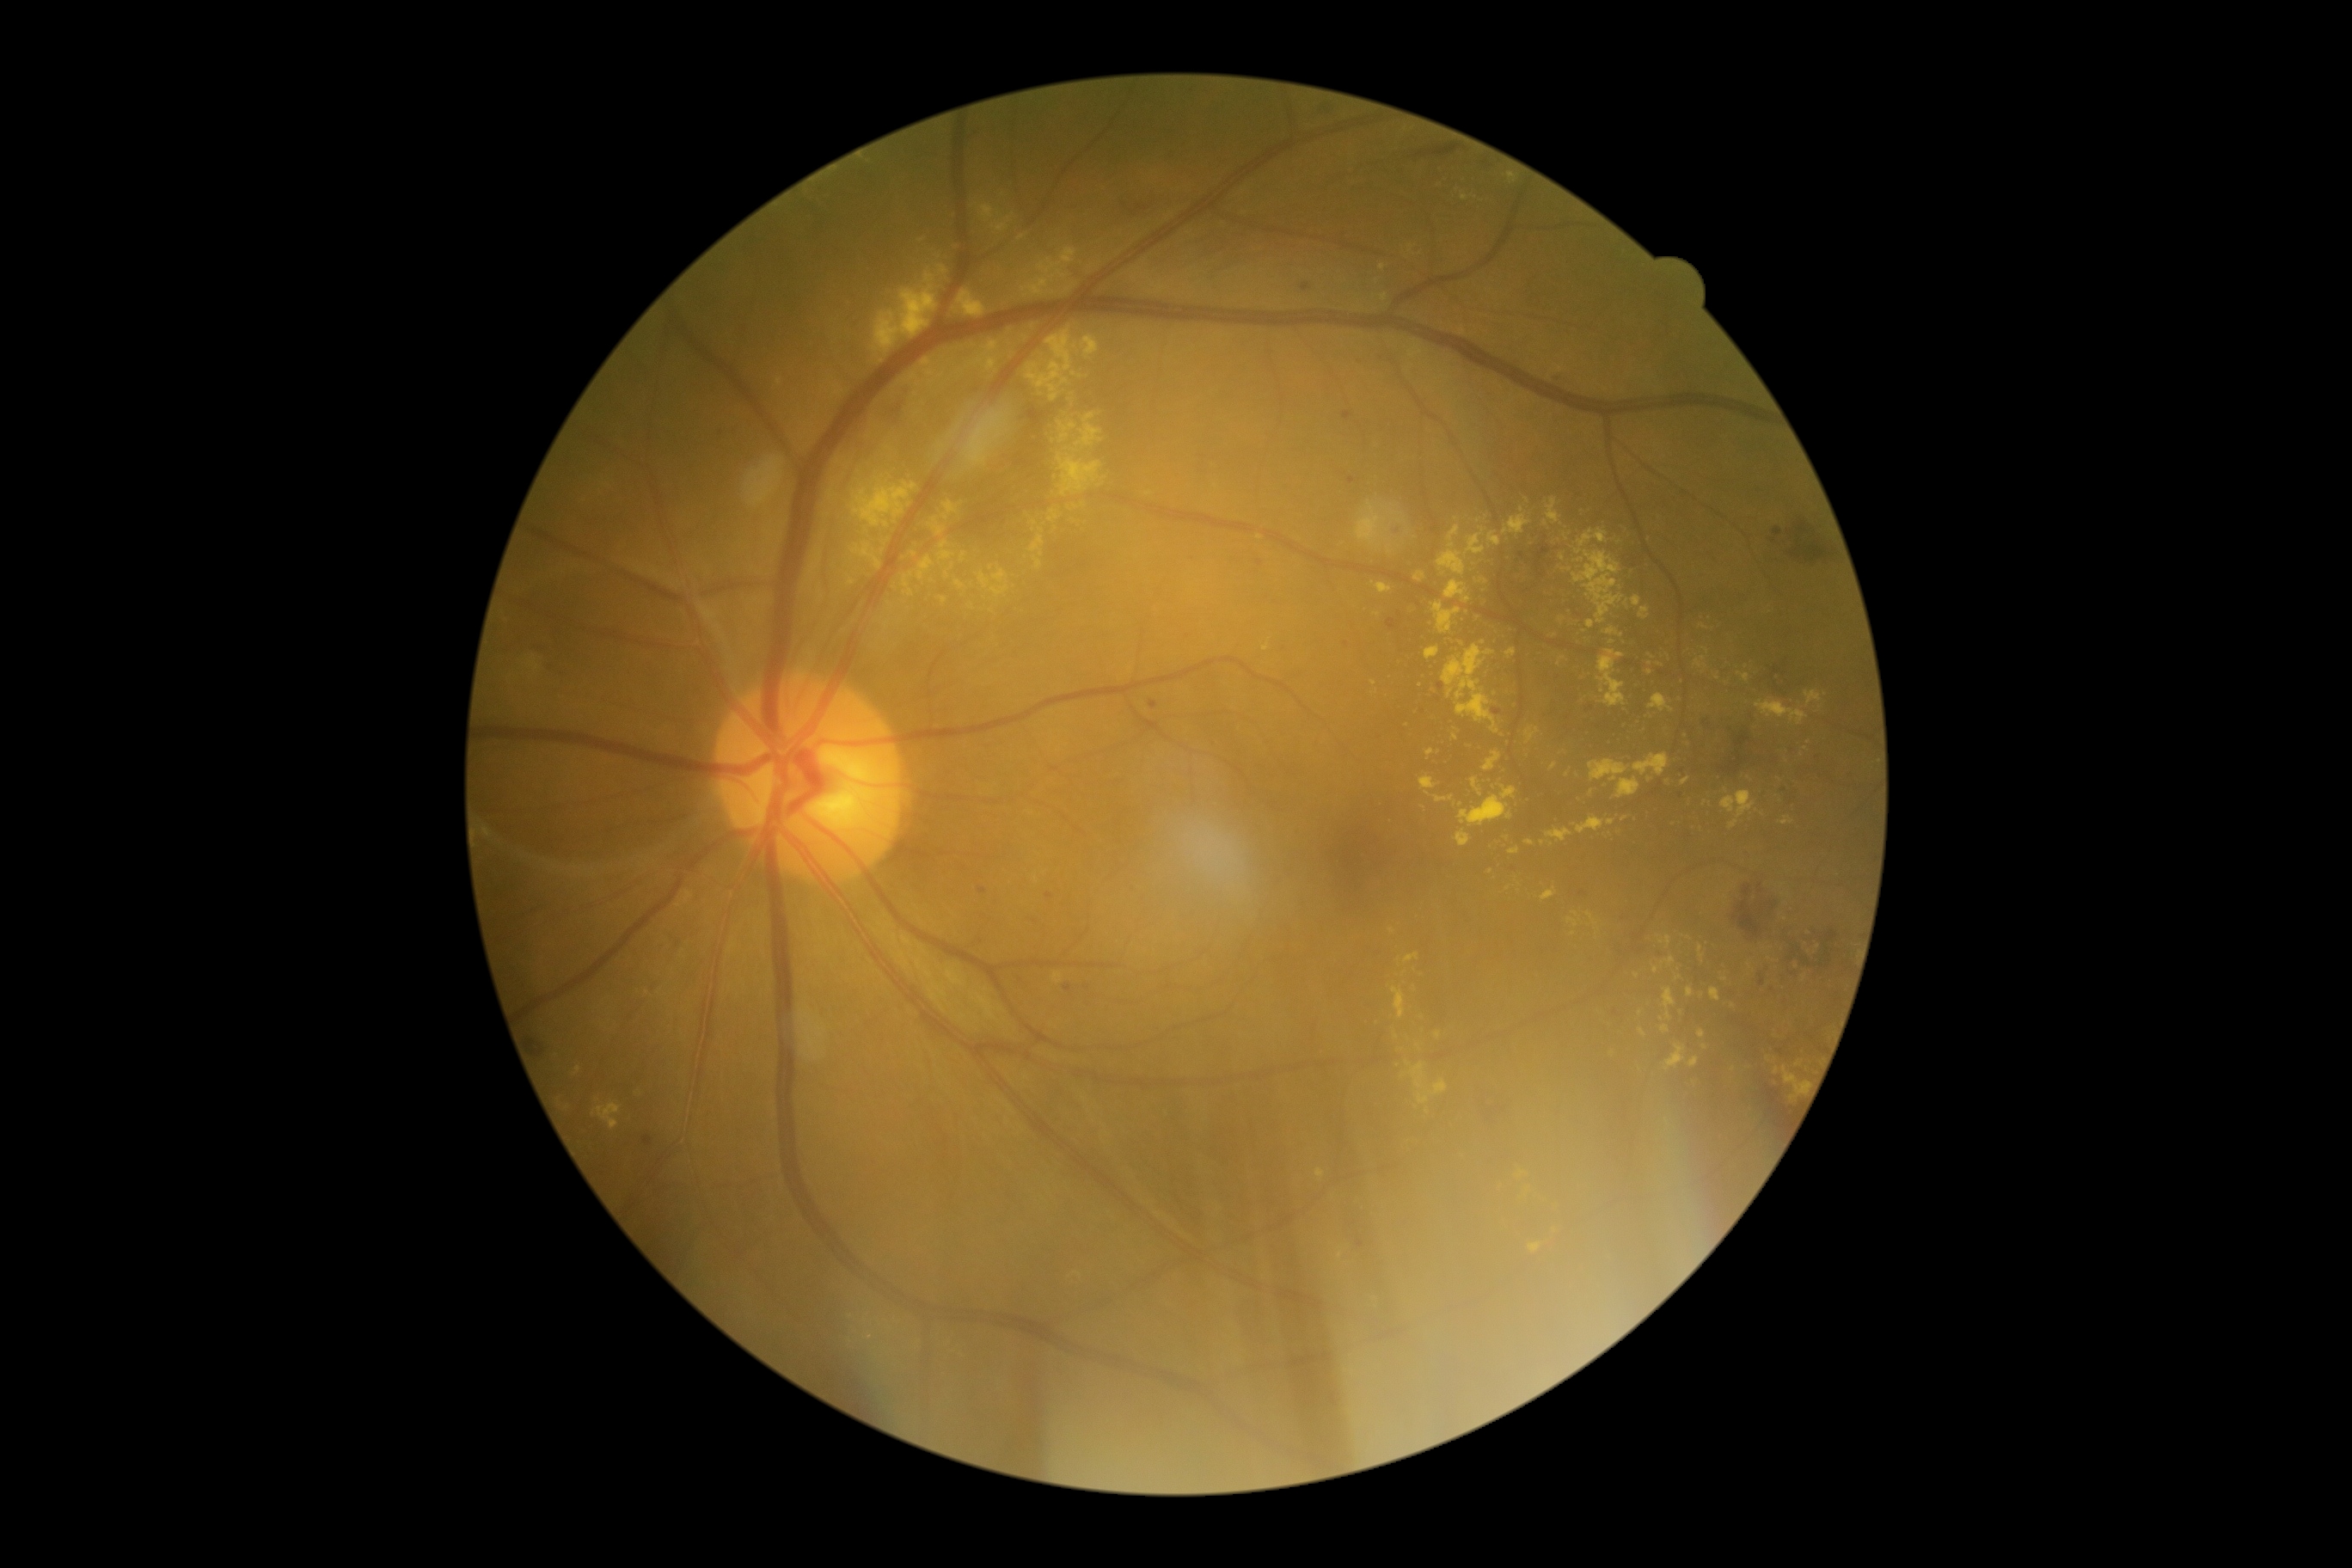
Diabetic retinopathy (DR) is grade 2
Lesions identified (partial list):
hard exudates (EXs) (subset) = 989/568/1010/597 | 1559/656/1565/666 | 971/341/1000/372 | 1057/455/1103/498 | 1488/532/1502/548 | 1588/912/1598/926 | 1660/936/1672/946 | 943/501/964/520 | 1739/673/1749/682 | 819/591/824/599 | 1419/776/1438/790
EXs (small, approximate centers) near [1373,682] | [1092,267] | [1522,509] | [1717,678] | [1377,614] | [1809,742] | [1626,604] | [944,600] | [1660,664]